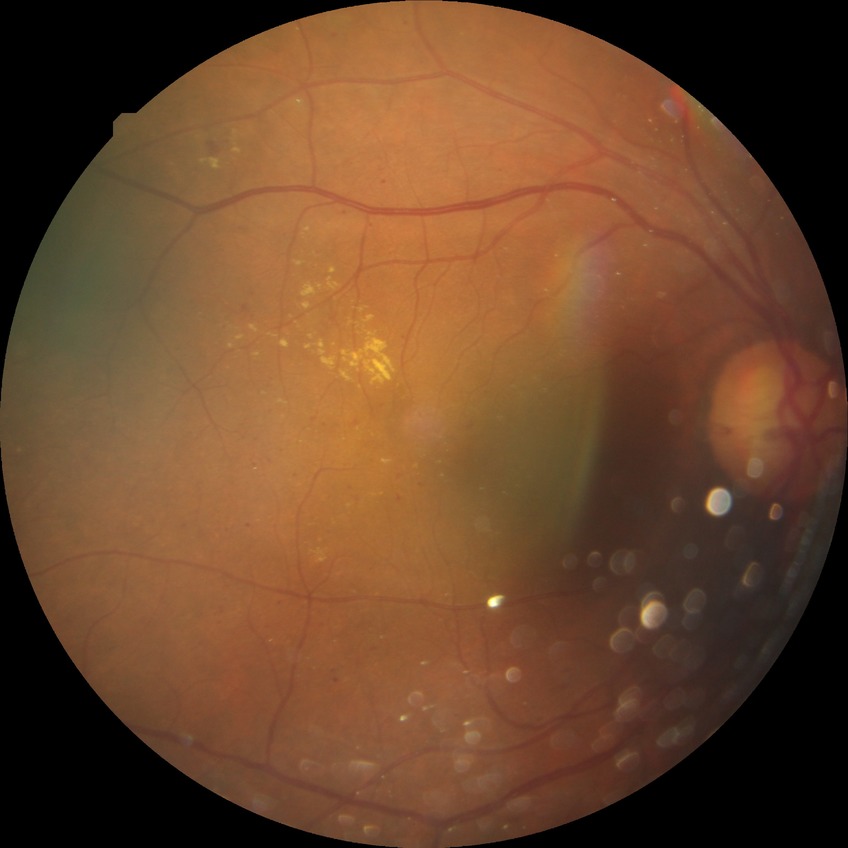
DR severity: SDR.